Camera: Clarity RetCam 3 (130° FOV) · 640 x 480 pixels · infant wide-field fundus photograph
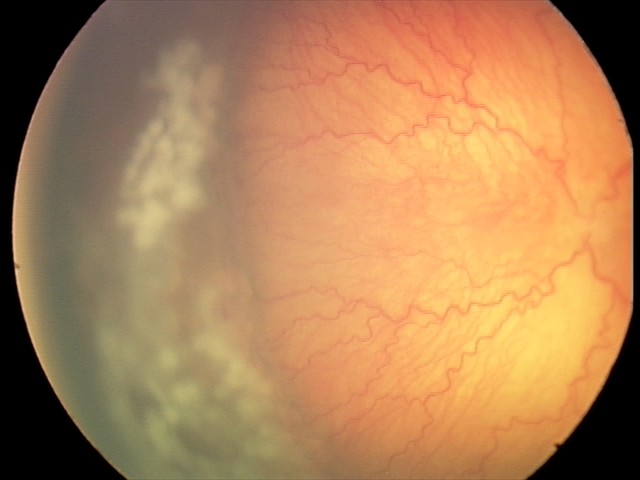

Plus disease was diagnosed. Screening series with aggressive retinopathy of prematurity.